Color fundus photograph, 2048x1536: 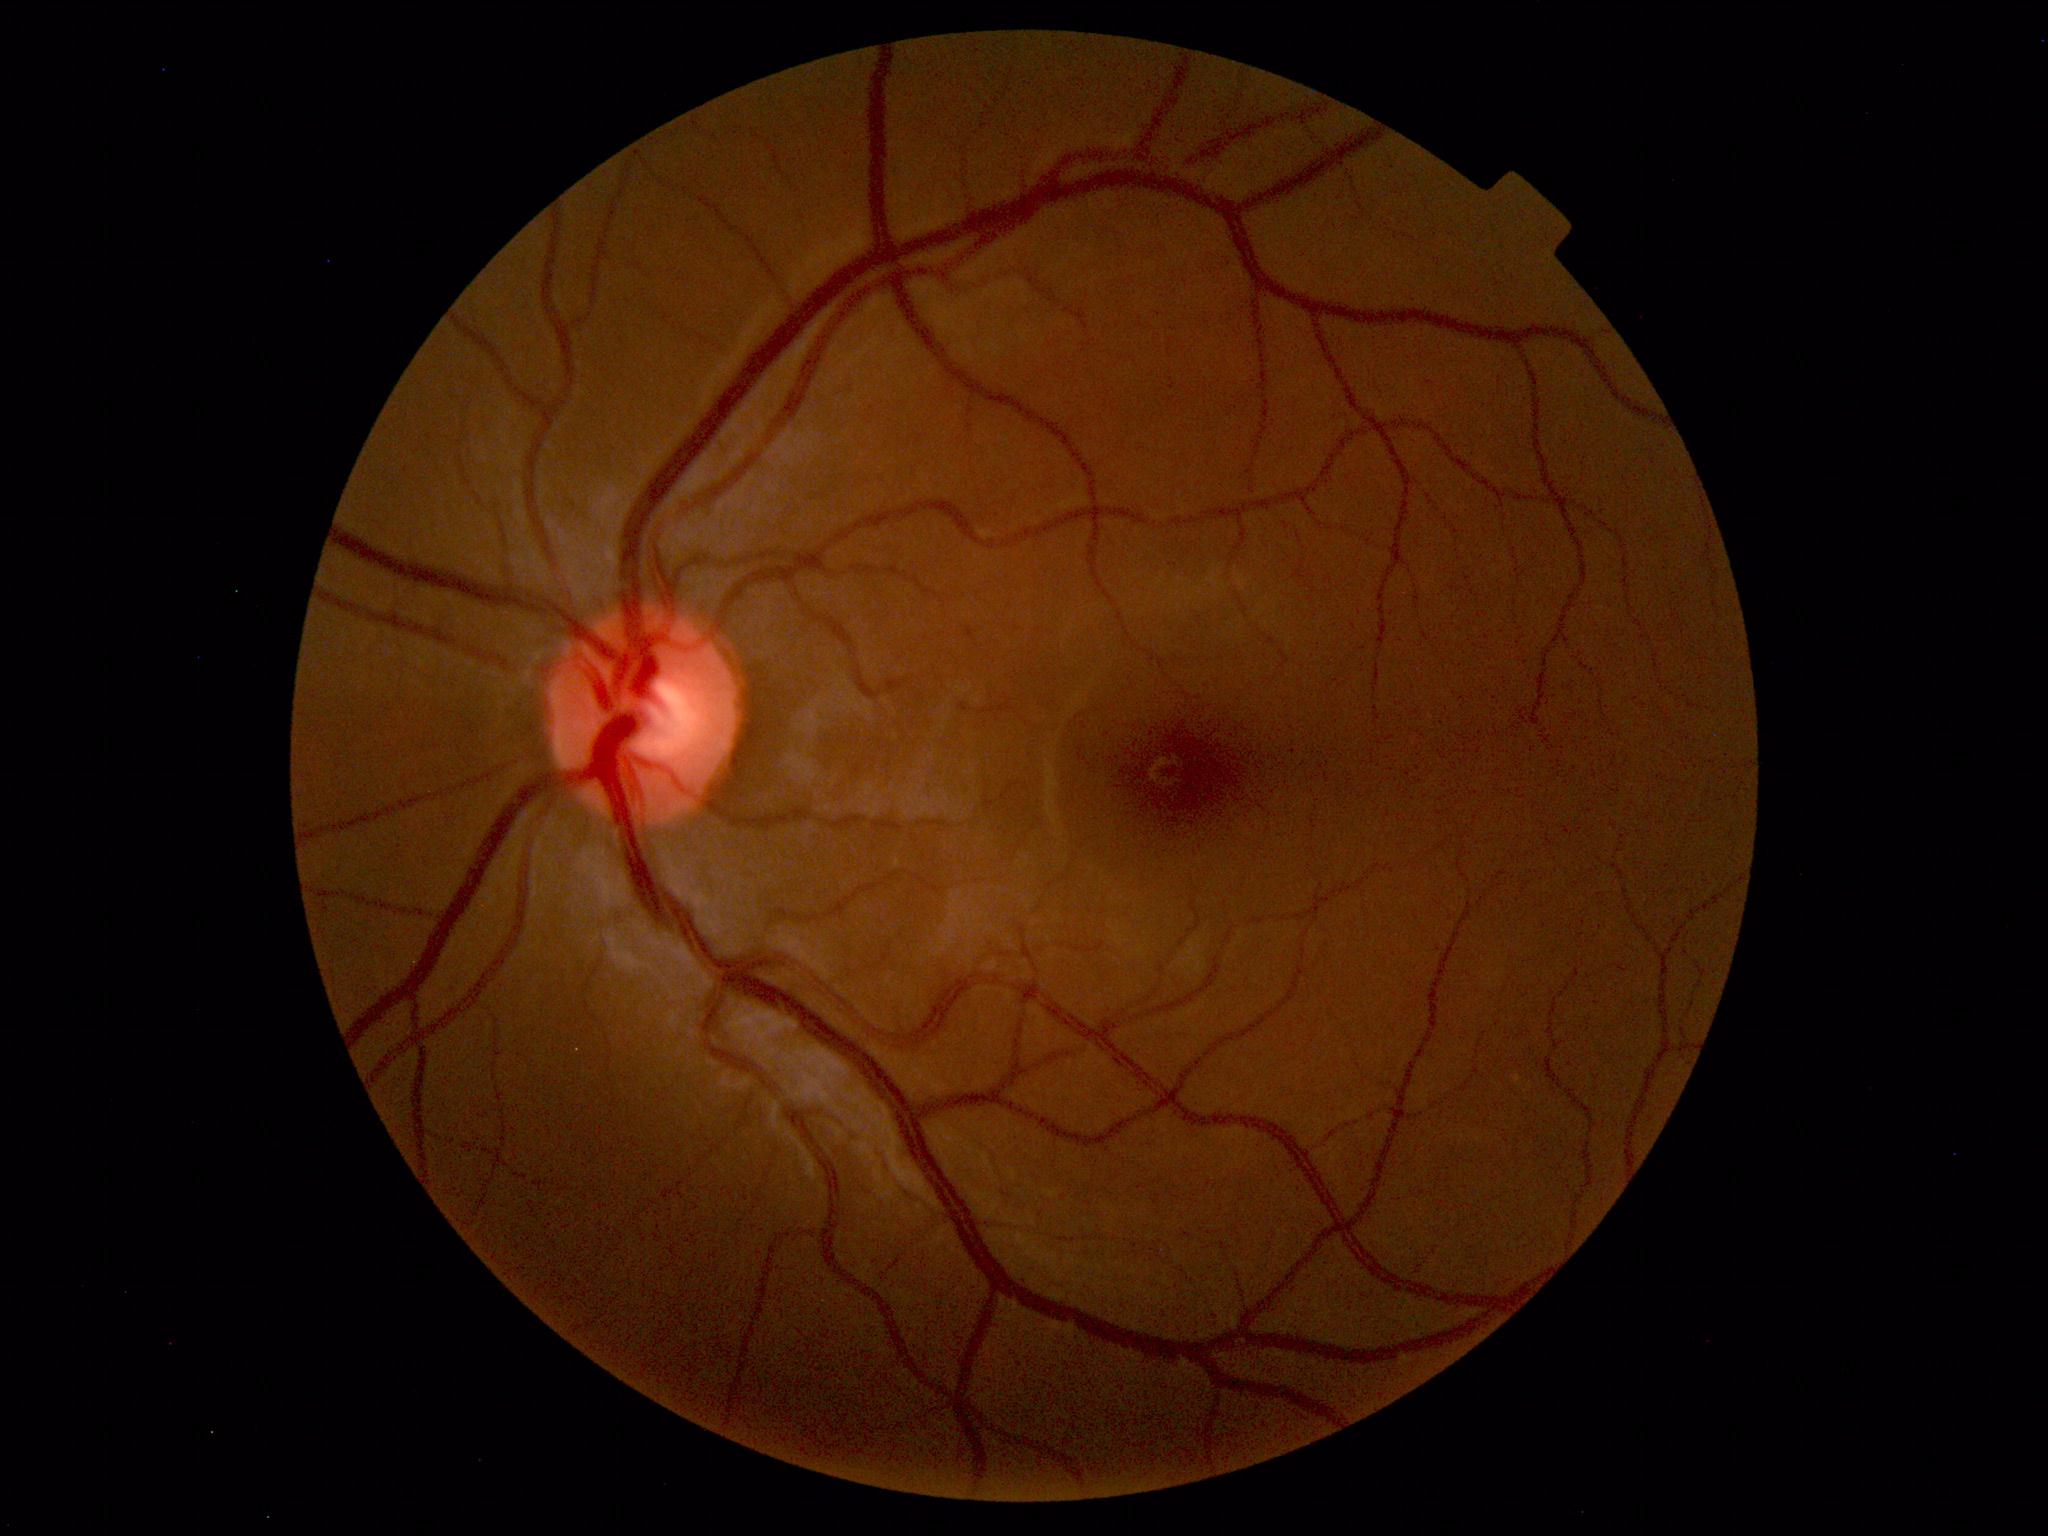 Within normal limits. No abnormalities identified.